CFP
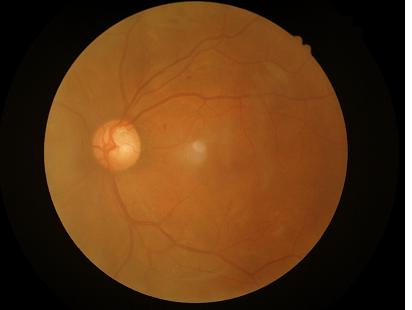
No over- or under-exposure. Optic disc, vessels, and background are in focus. Overall quality is good and the image is gradable.